NIDEK AFC-230
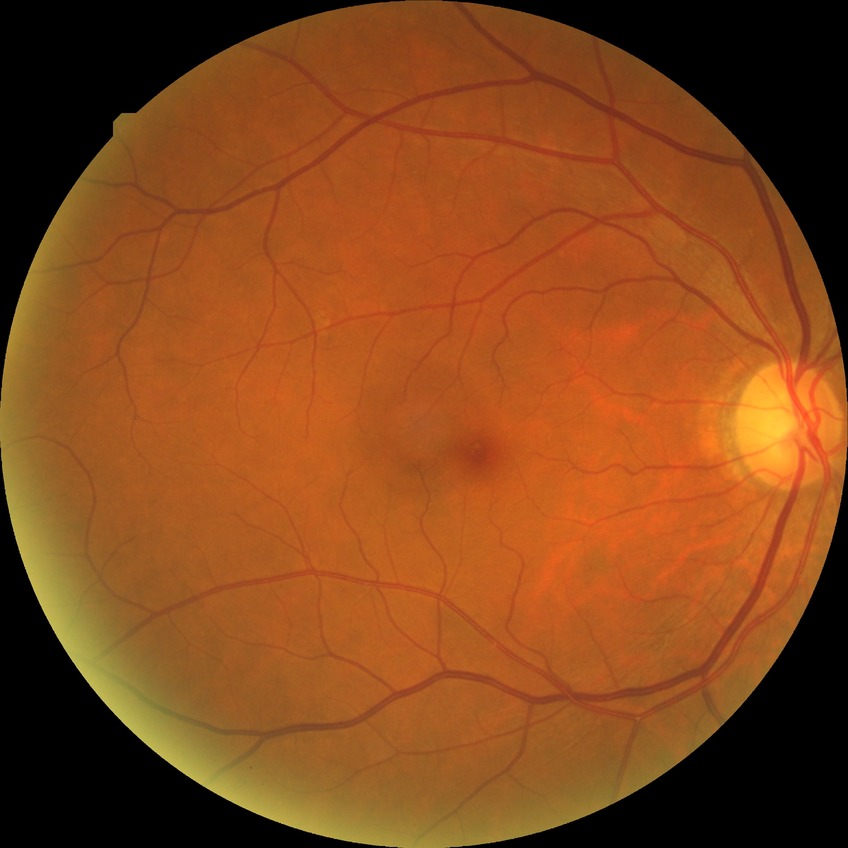
Diabetic retinopathy (DR): no diabetic retinopathy (NDR).